2212x1661. FOV: 30 degrees. Non-mydriatic acquisition. Camera: Topcon TRC-NW400. Optic disc-centered. Retinal fundus photograph.
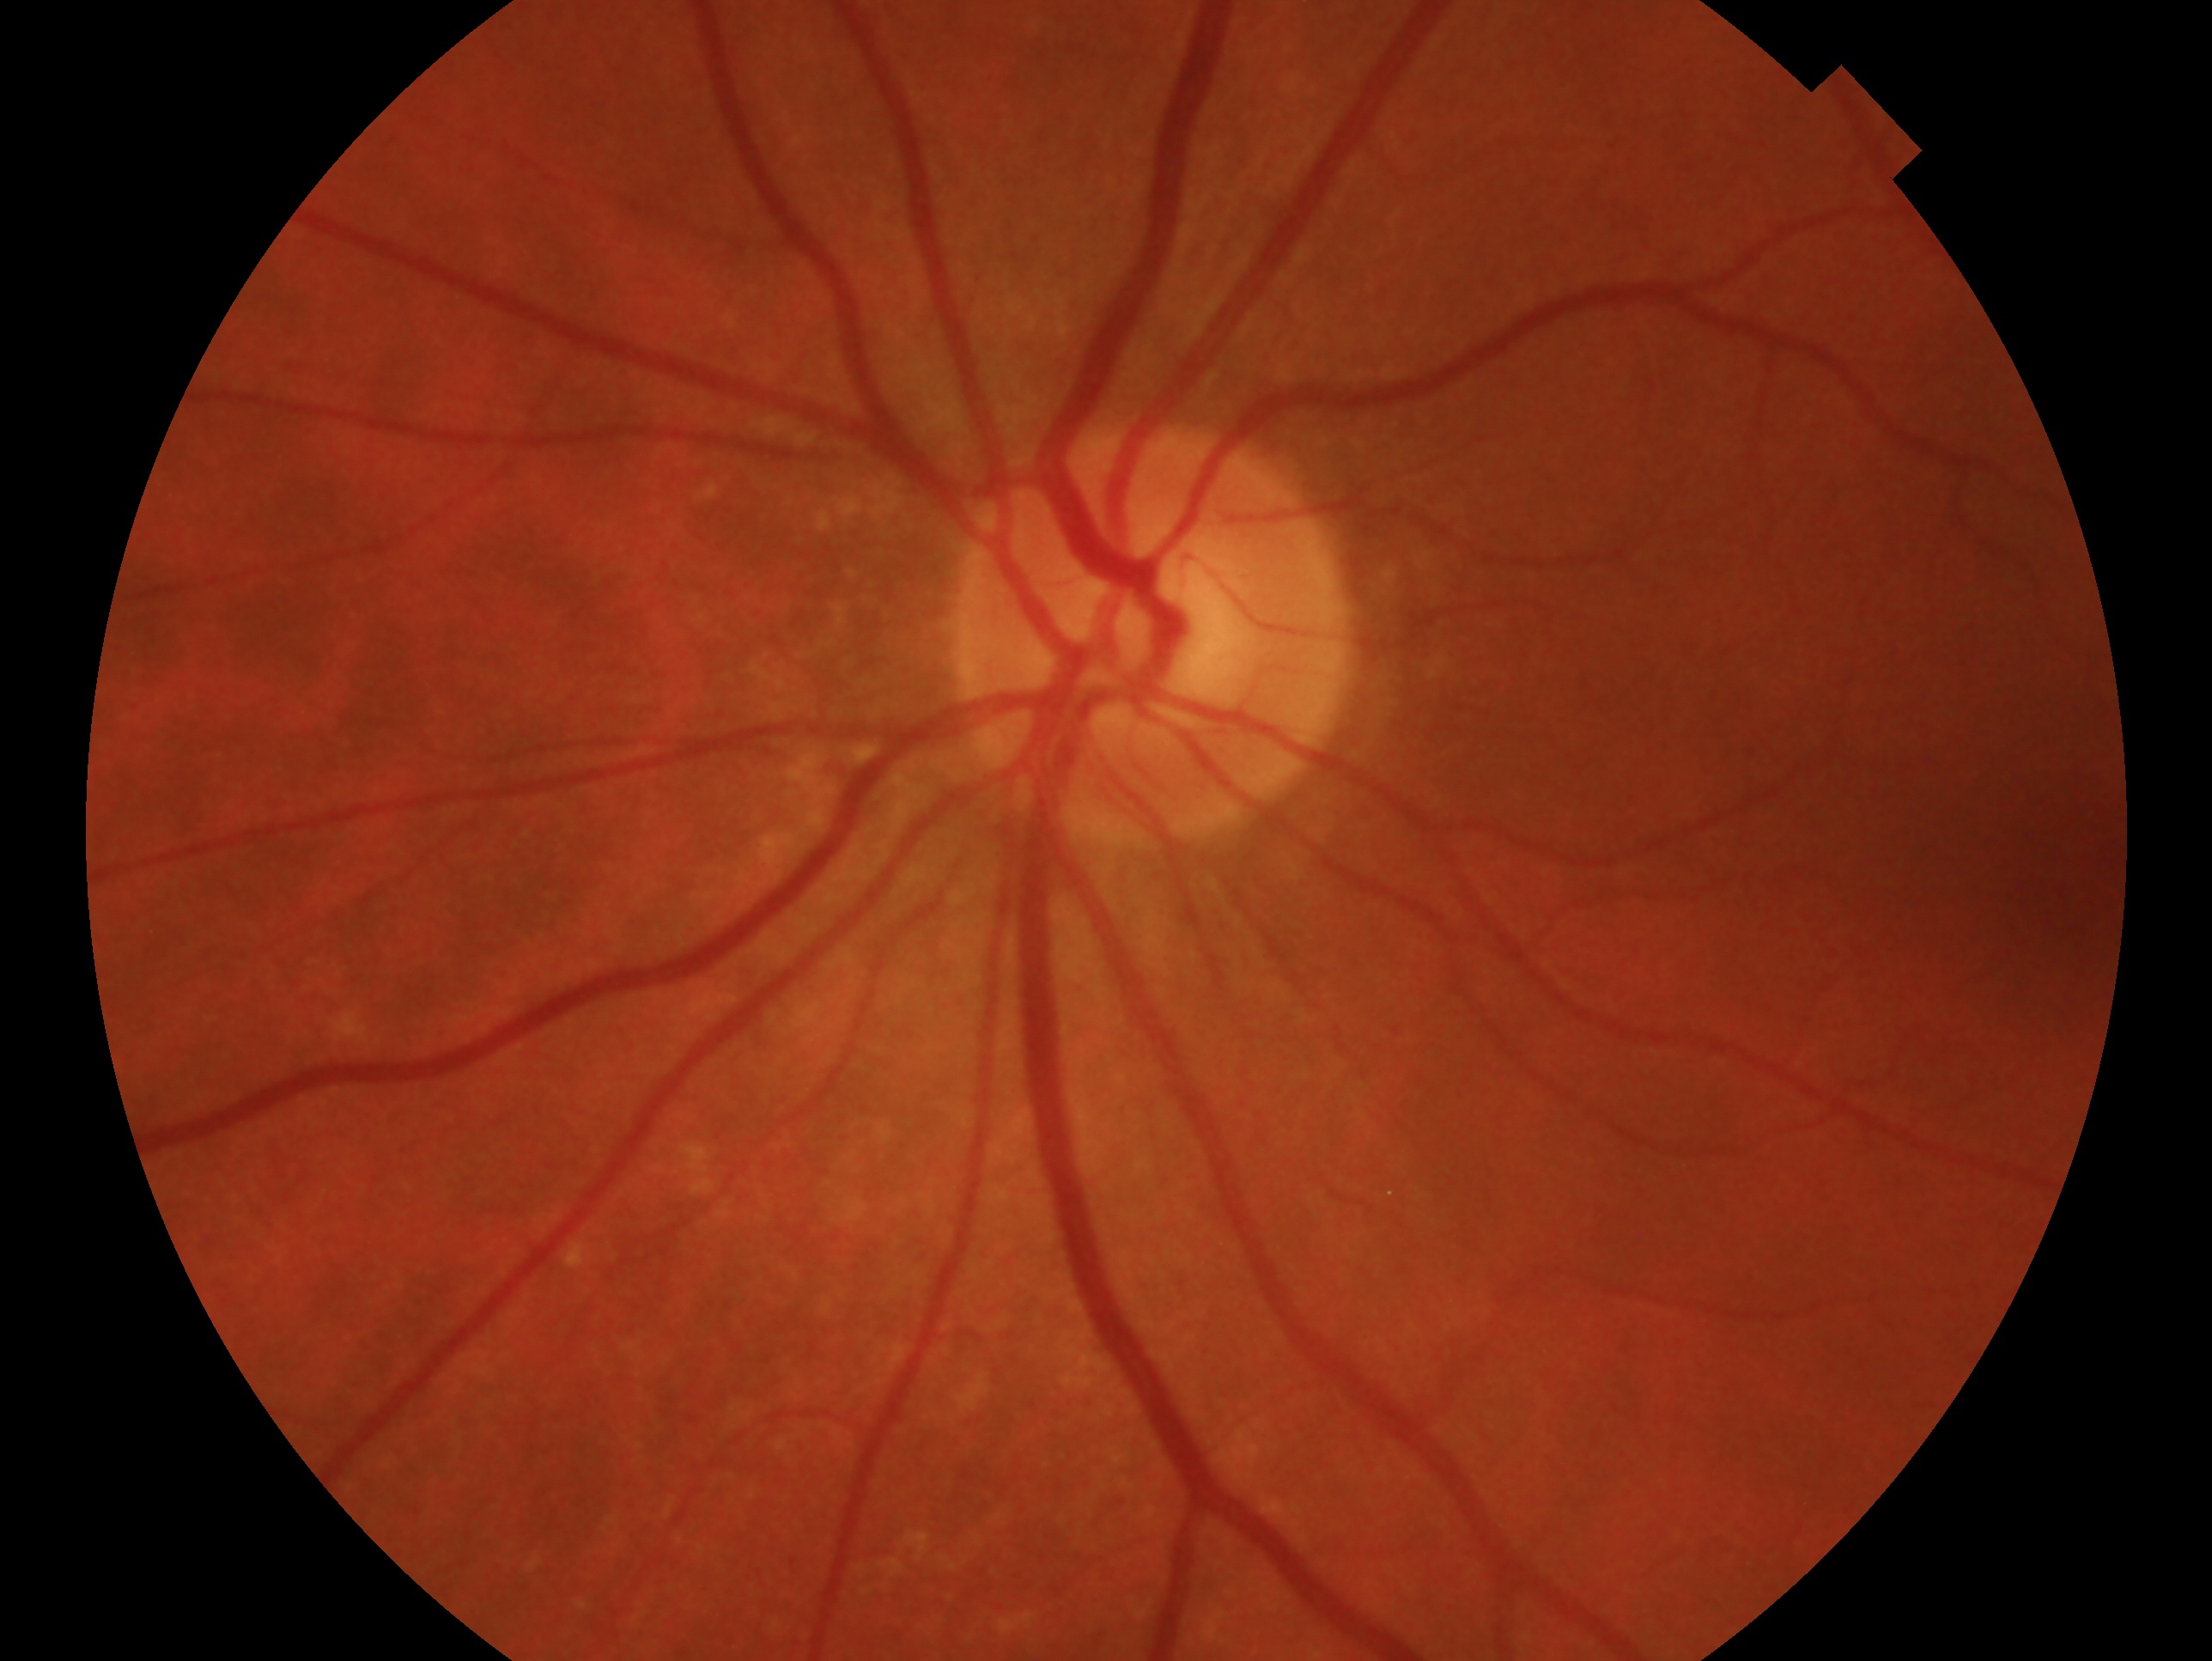

Eye: left eye. Diagnosis — no signs of glaucoma.